Pediatric retinal photograph (wide-field)
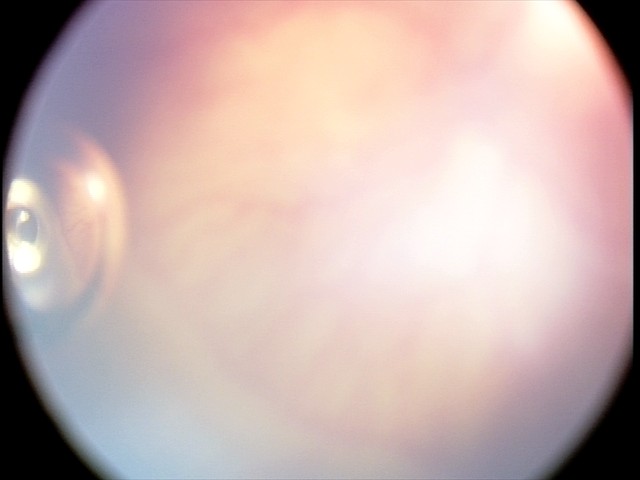 Assessment: plus disease; aggressive retinopathy of prematurity.